45 degree fundus photograph. Without pupil dilation. 848 x 848 pixels. NIDEK AFC-230 fundus camera: 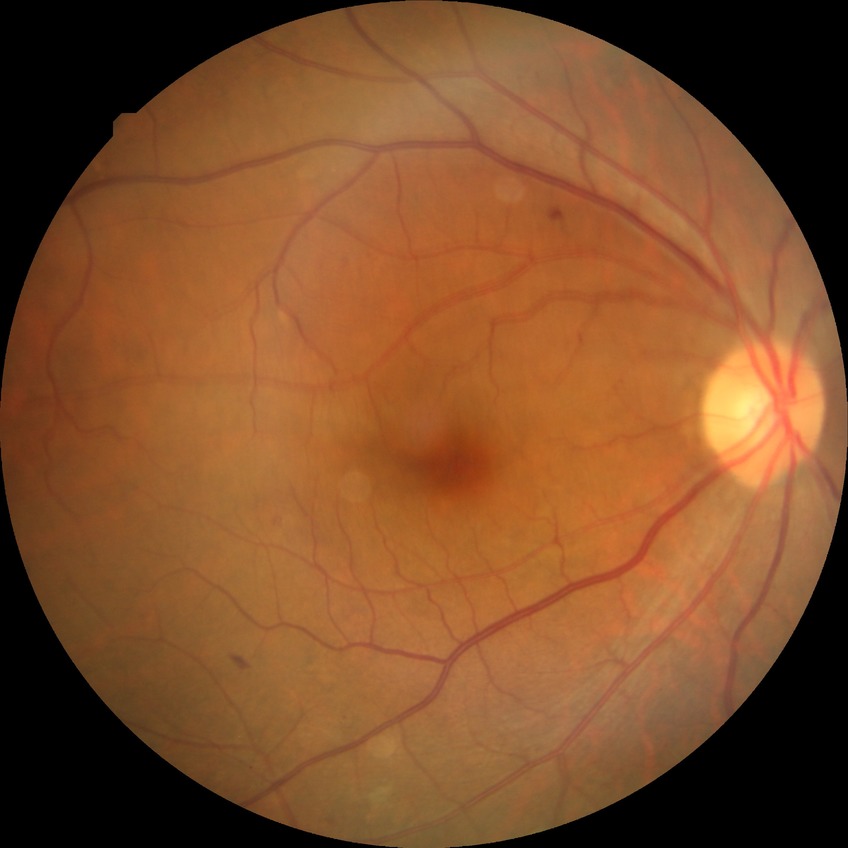 DR is PPDR.